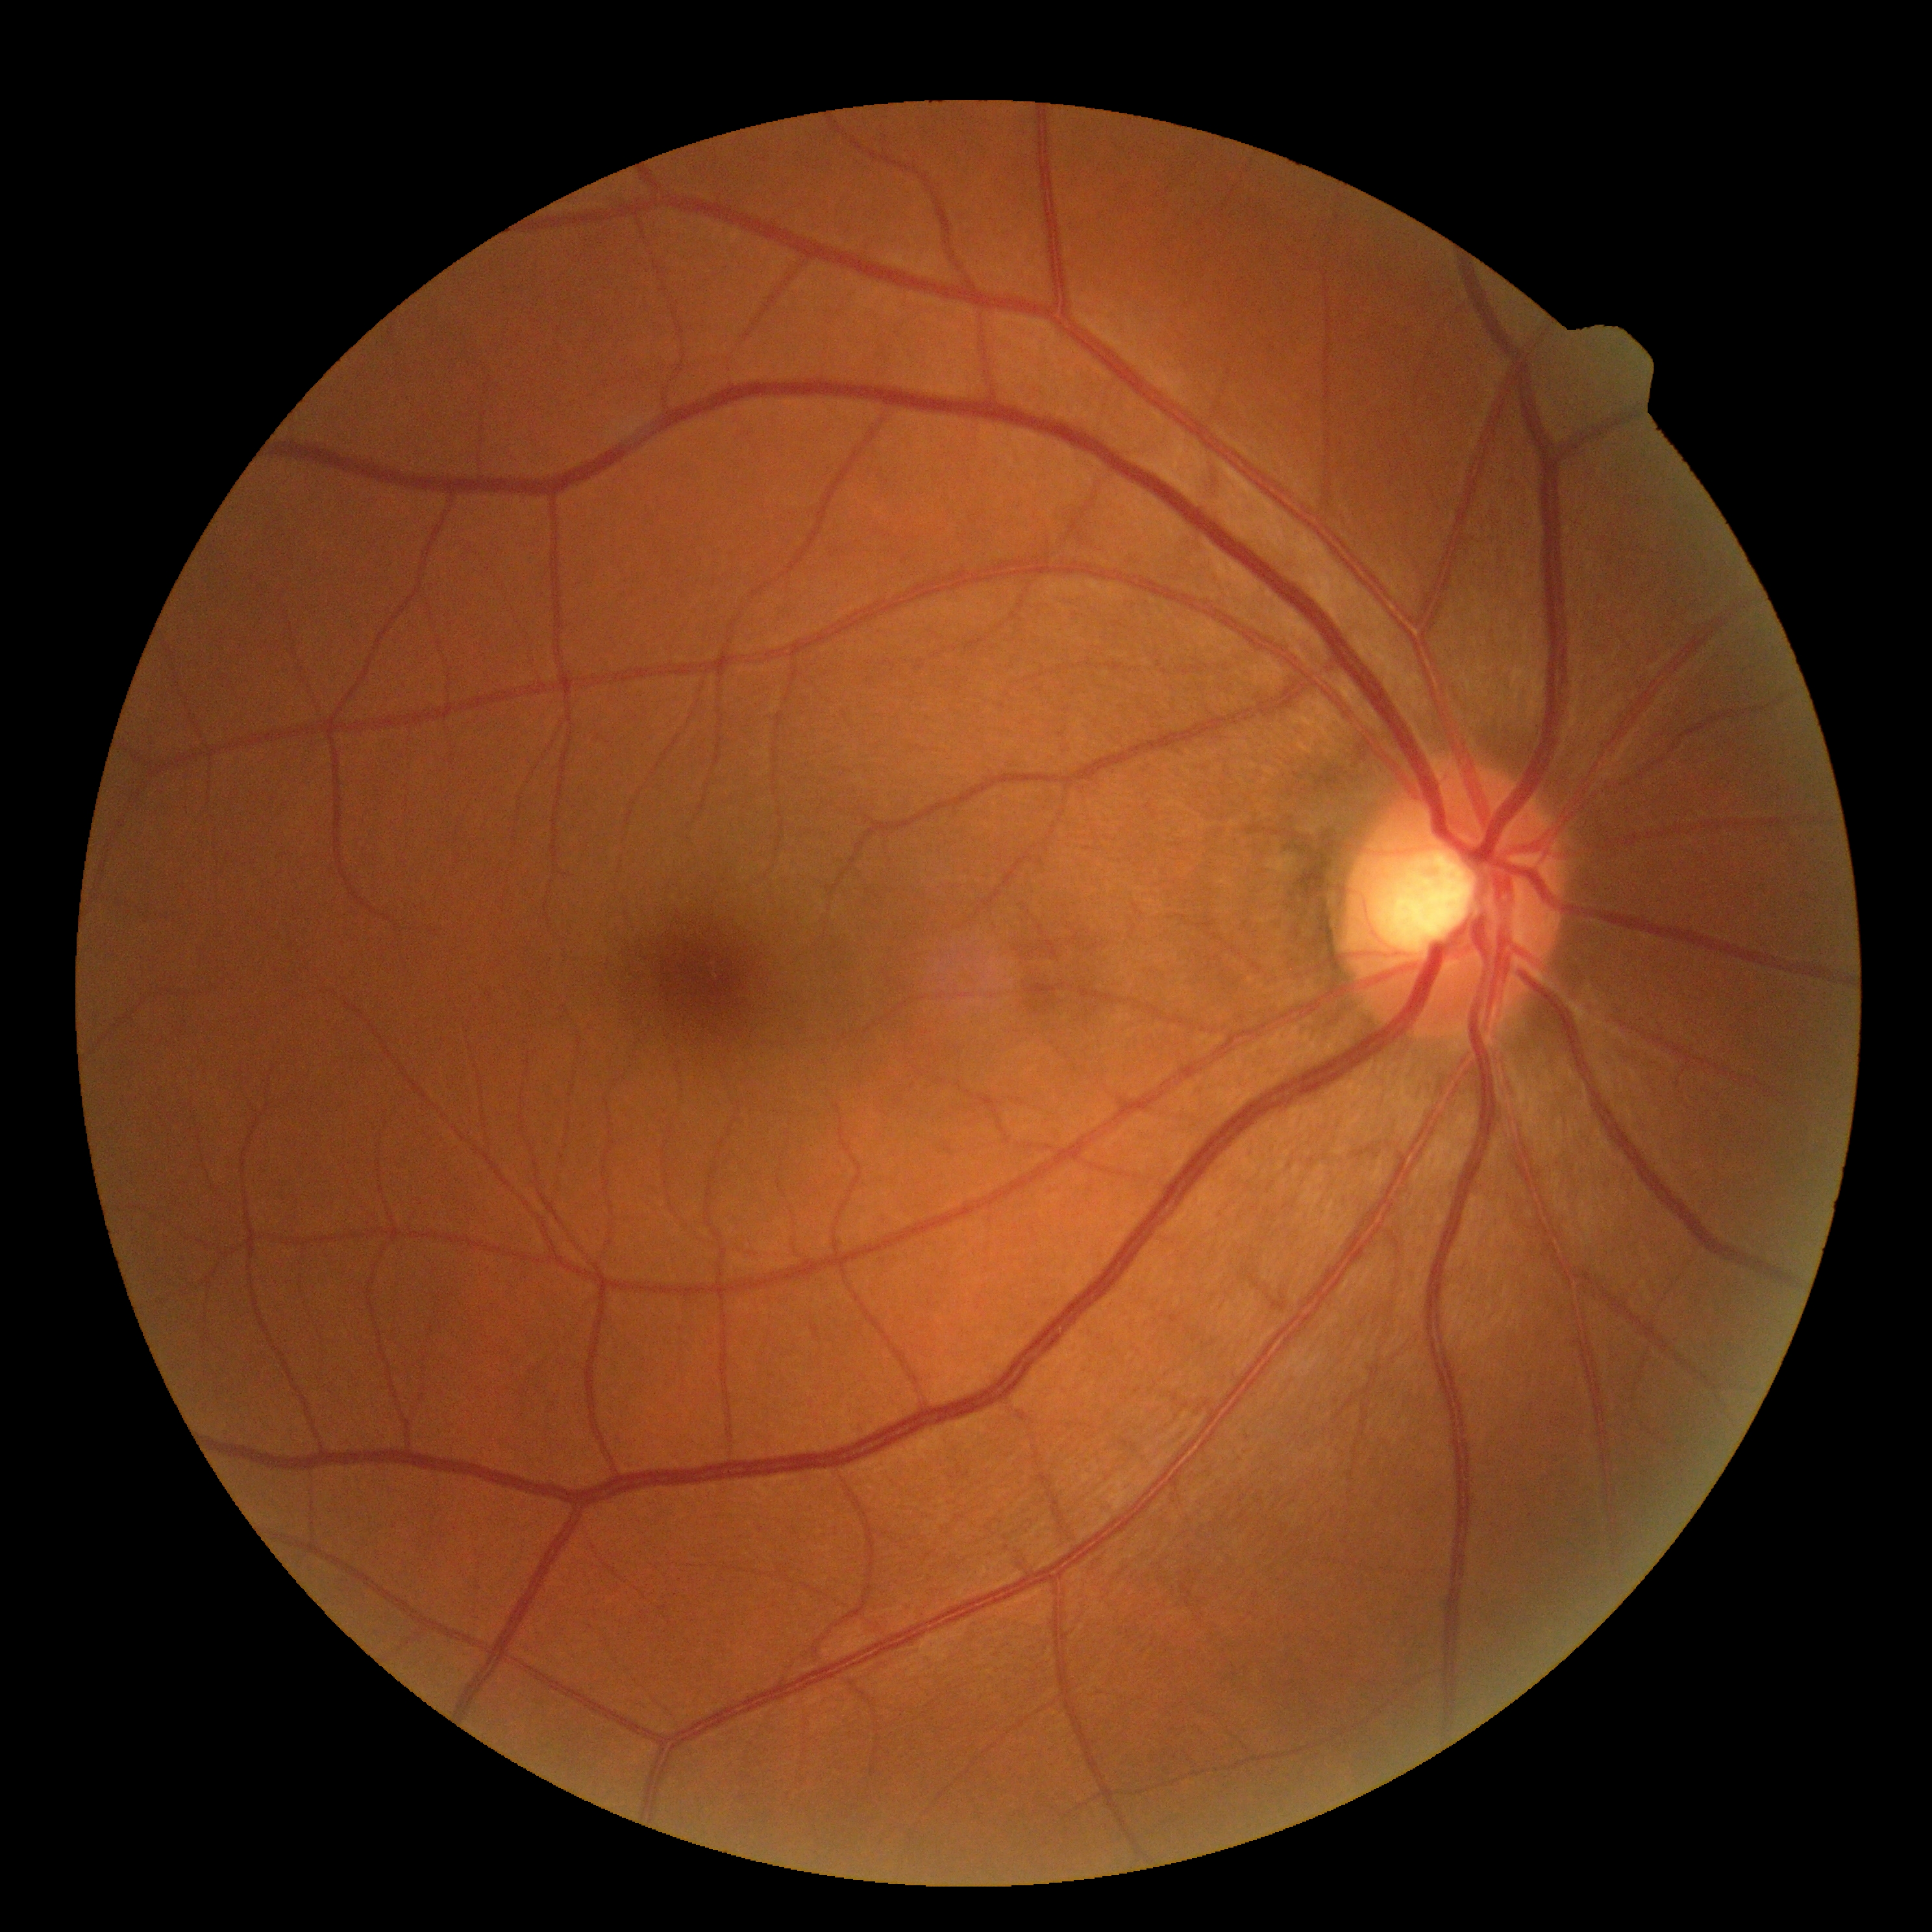

Retinopathy grade: 0. No diabetic retinal disease findings.